45° field of view: 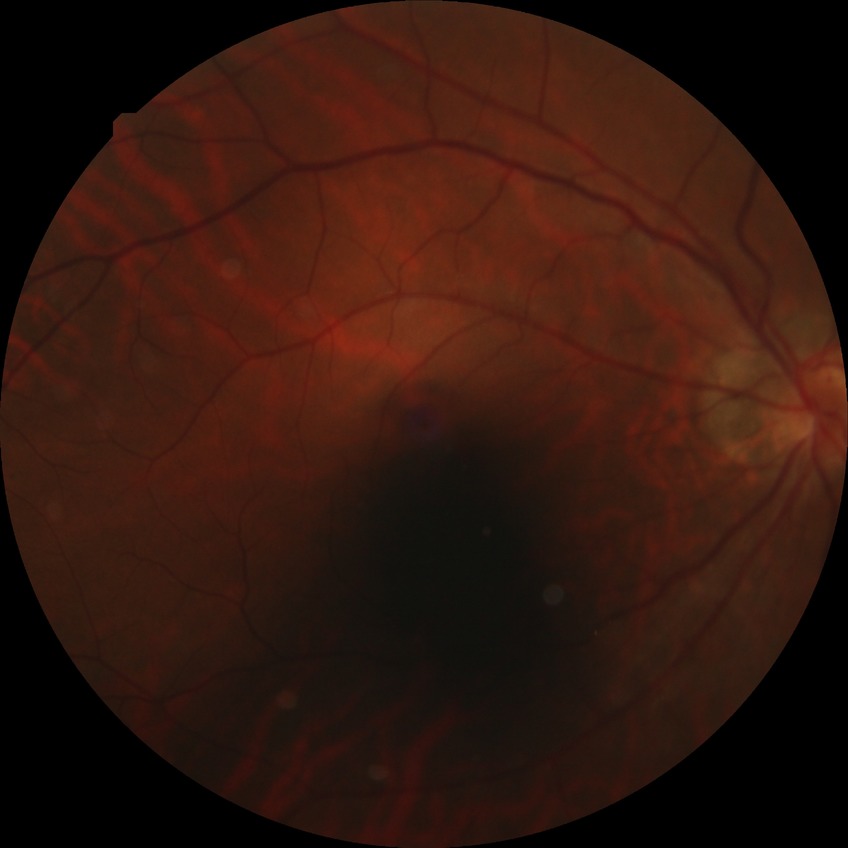
Davis grading: no diabetic retinopathy.